Infant wide-field retinal image; Natus RetCam Envision, 130° FOV.
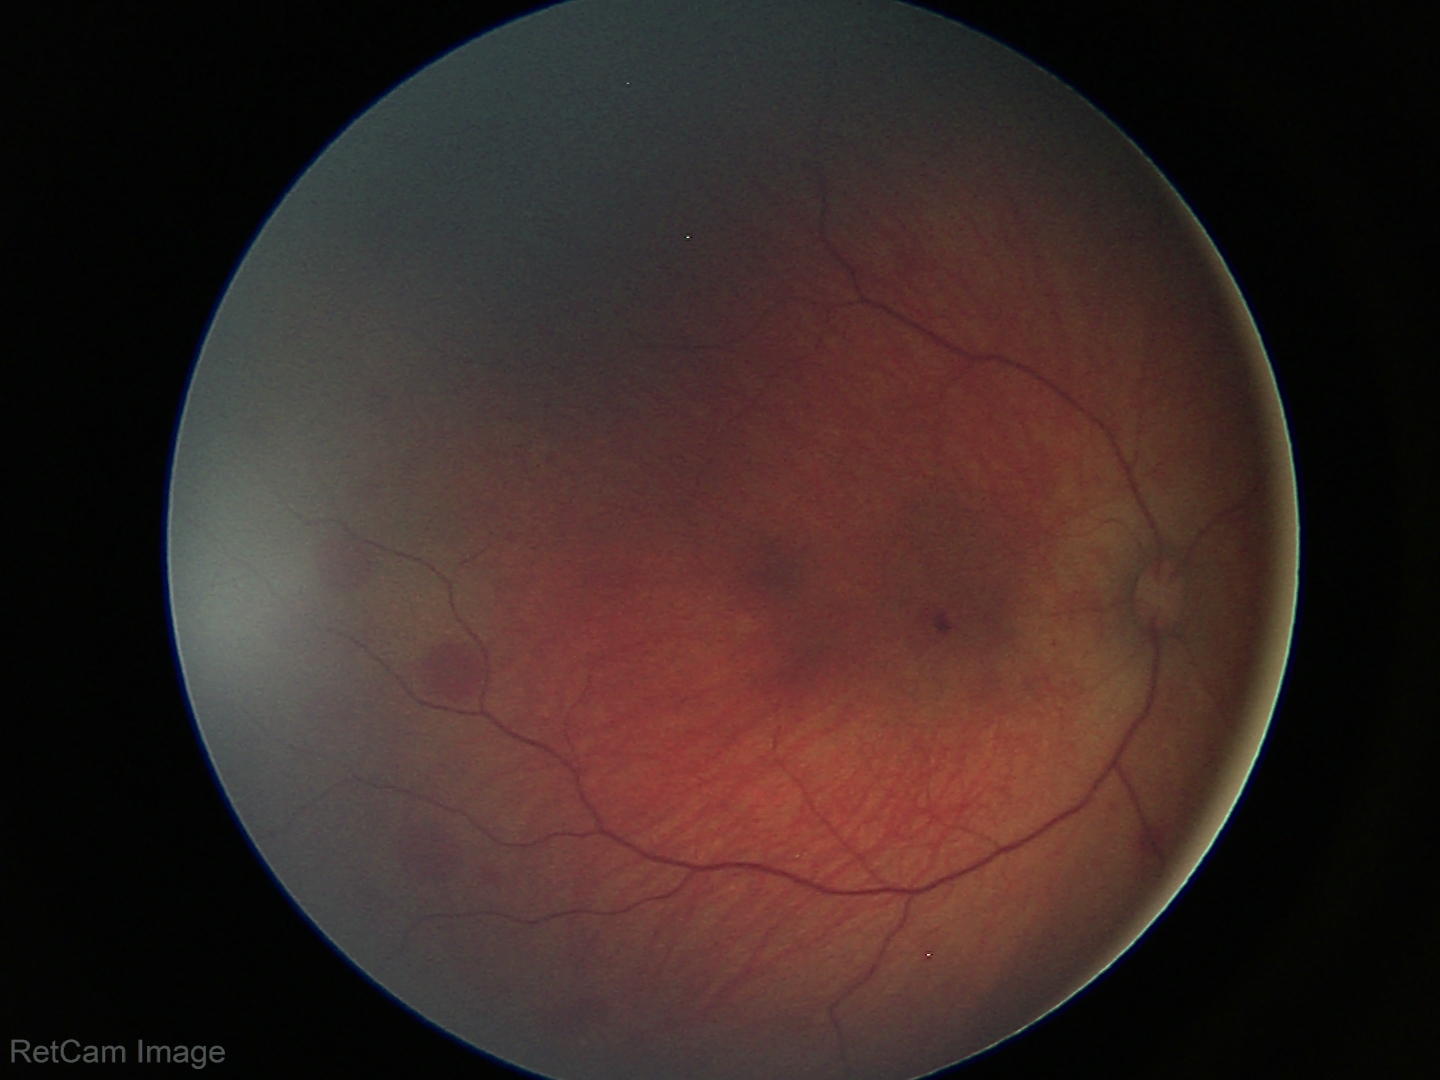
From an examination with diagnosis of retinal hemorrhages.